Posterior pole field covering the optic disc and macula. Color fundus photograph: 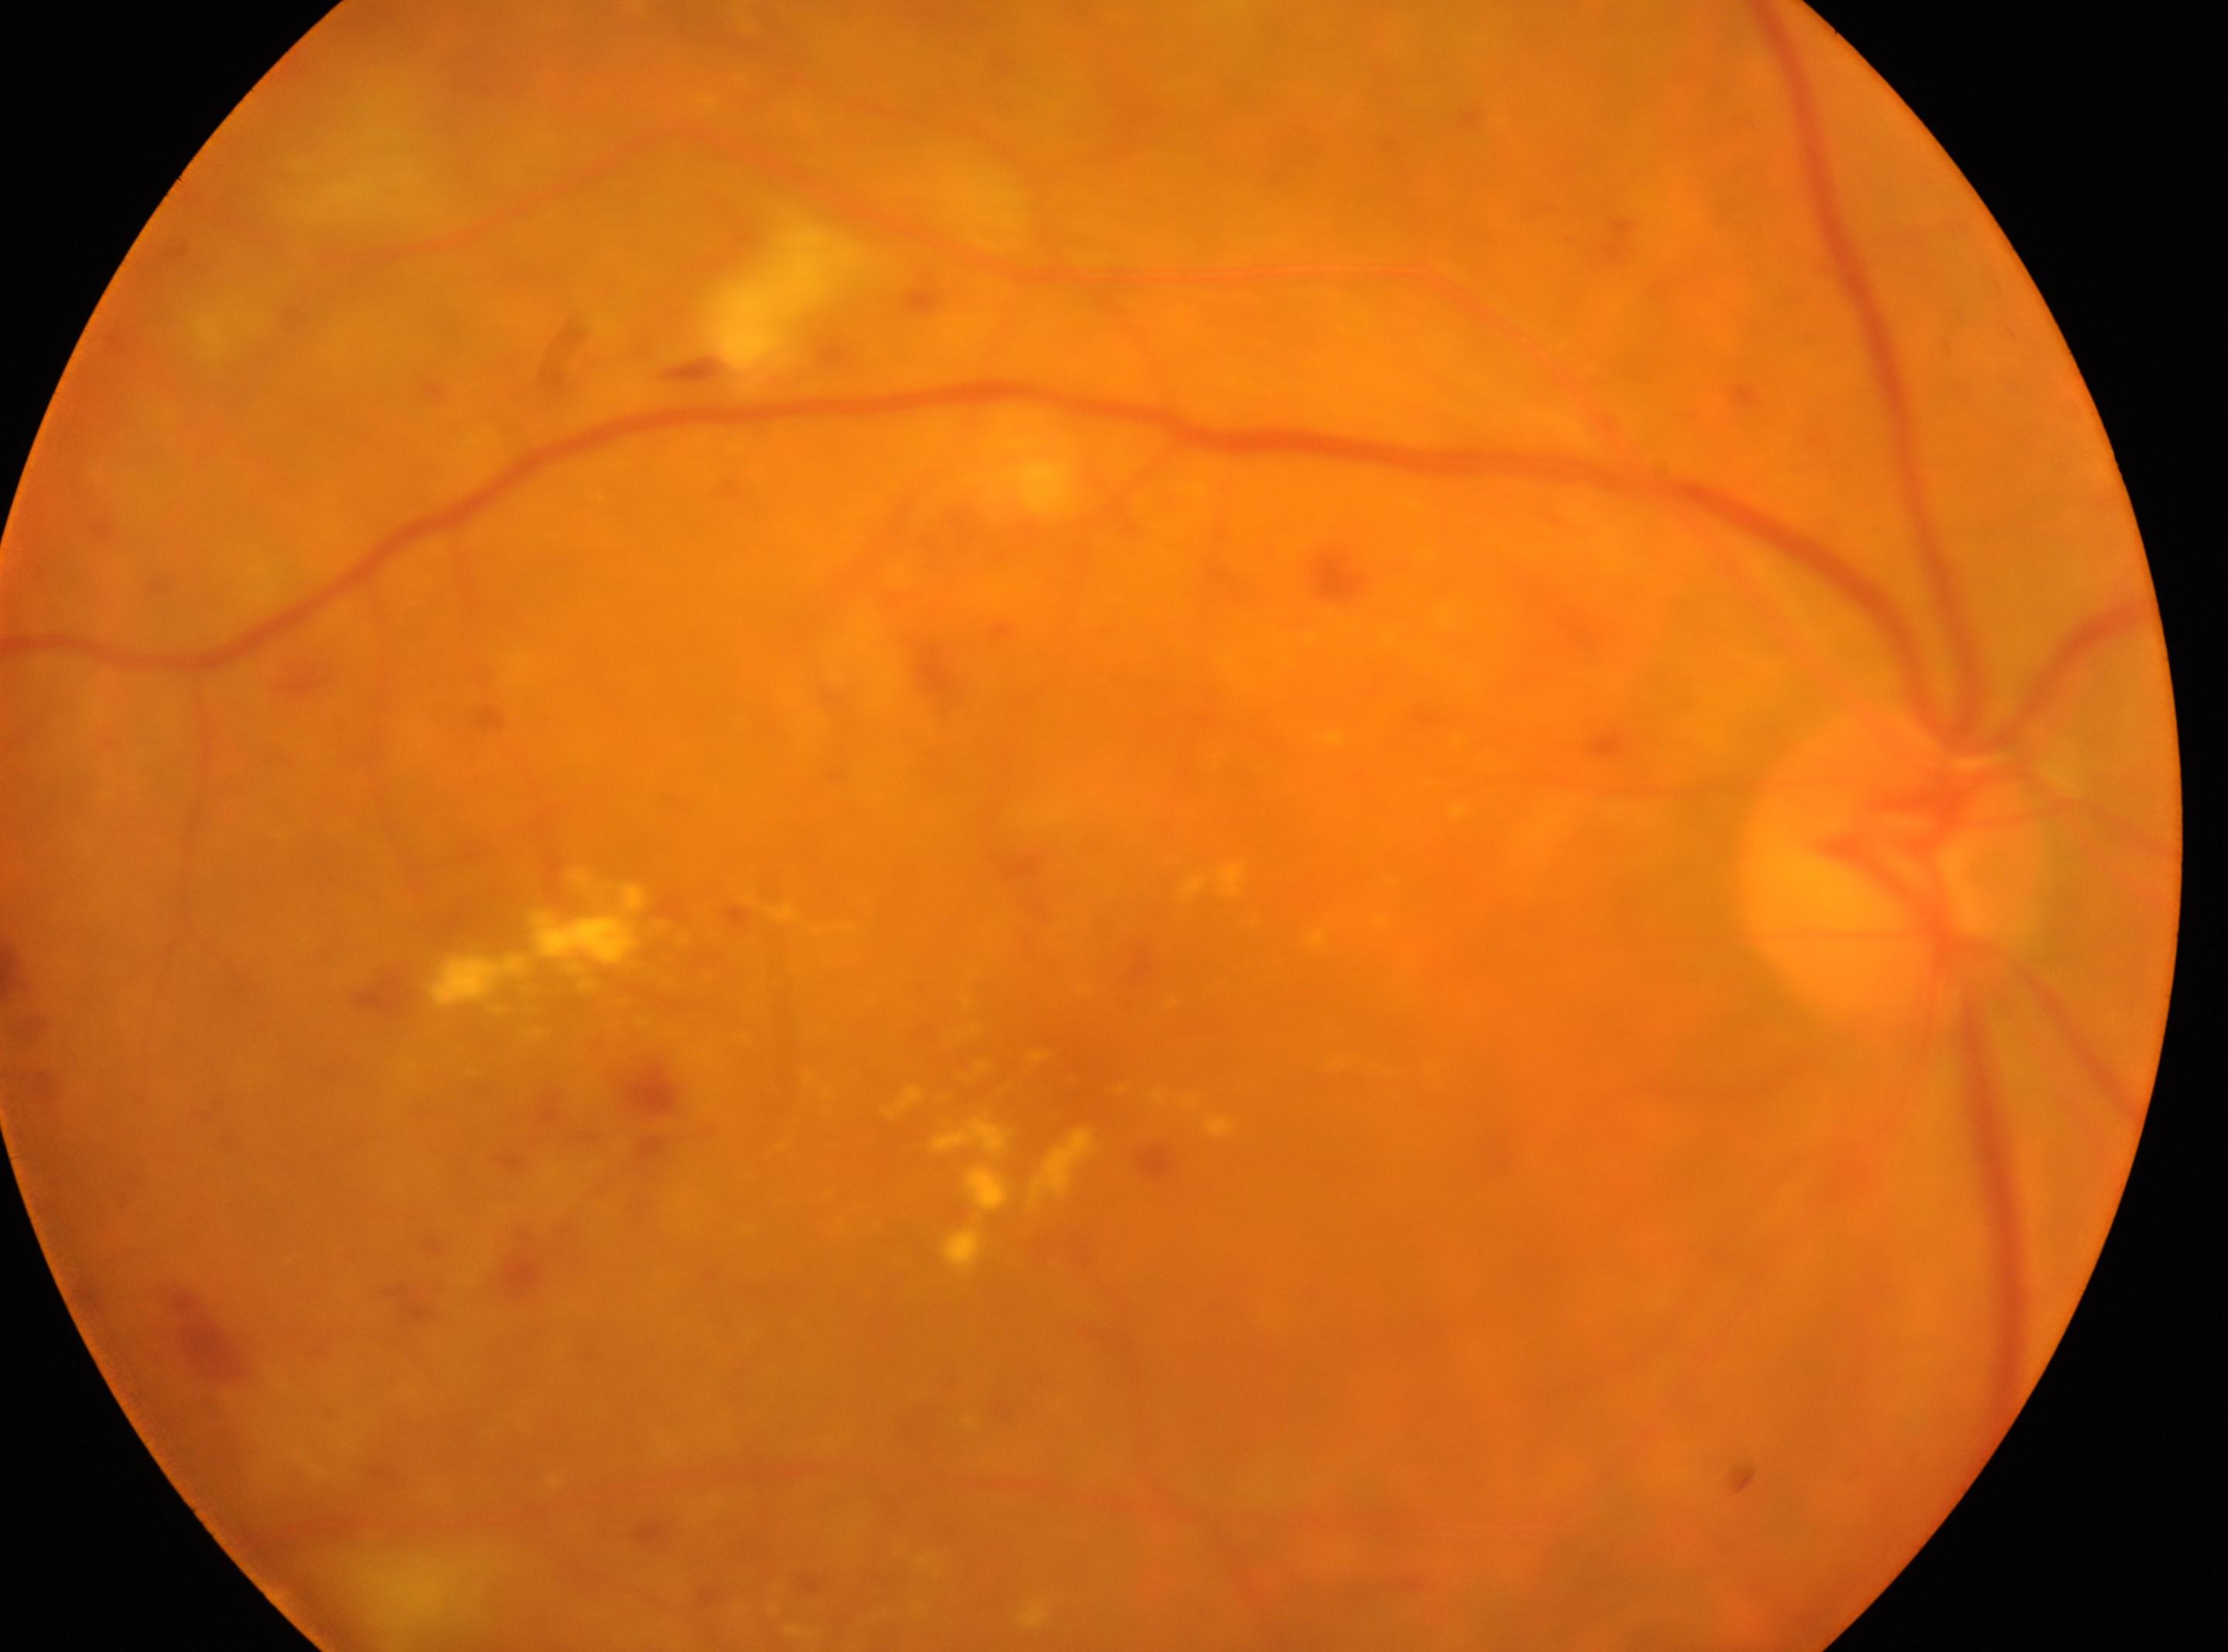

fovea center = (x: 1100, y: 1056); laterality = right eye; the optic disc = (x: 1888, y: 860); DR severity = 2.